Camera: NIDEK AFC-230:
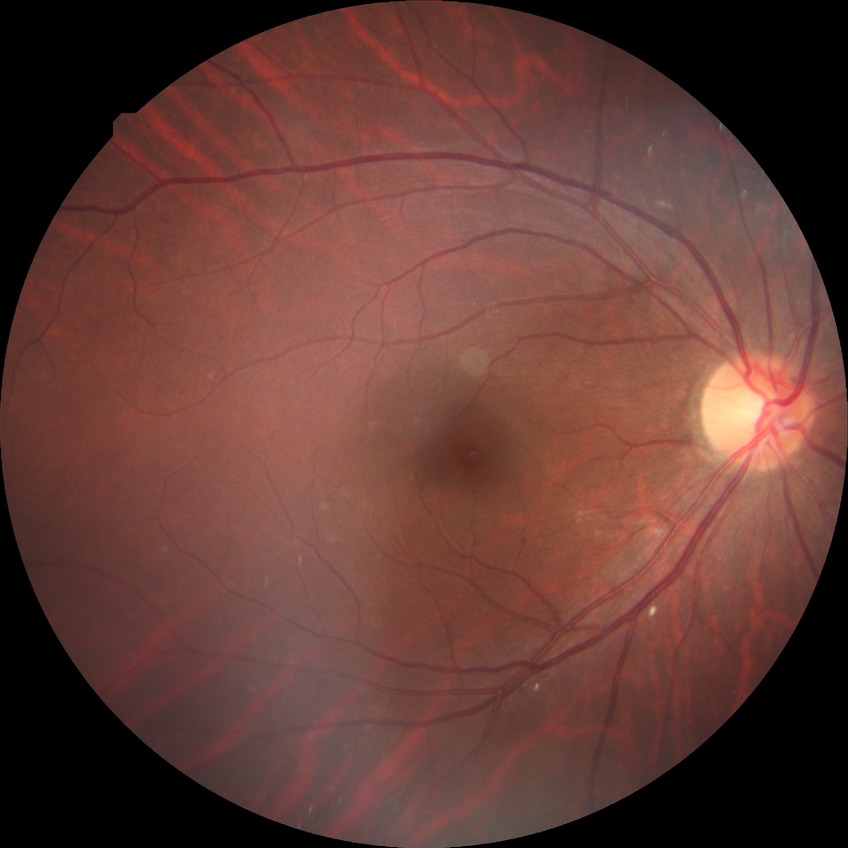

Diabetic retinopathy grade: no diabetic retinopathy.